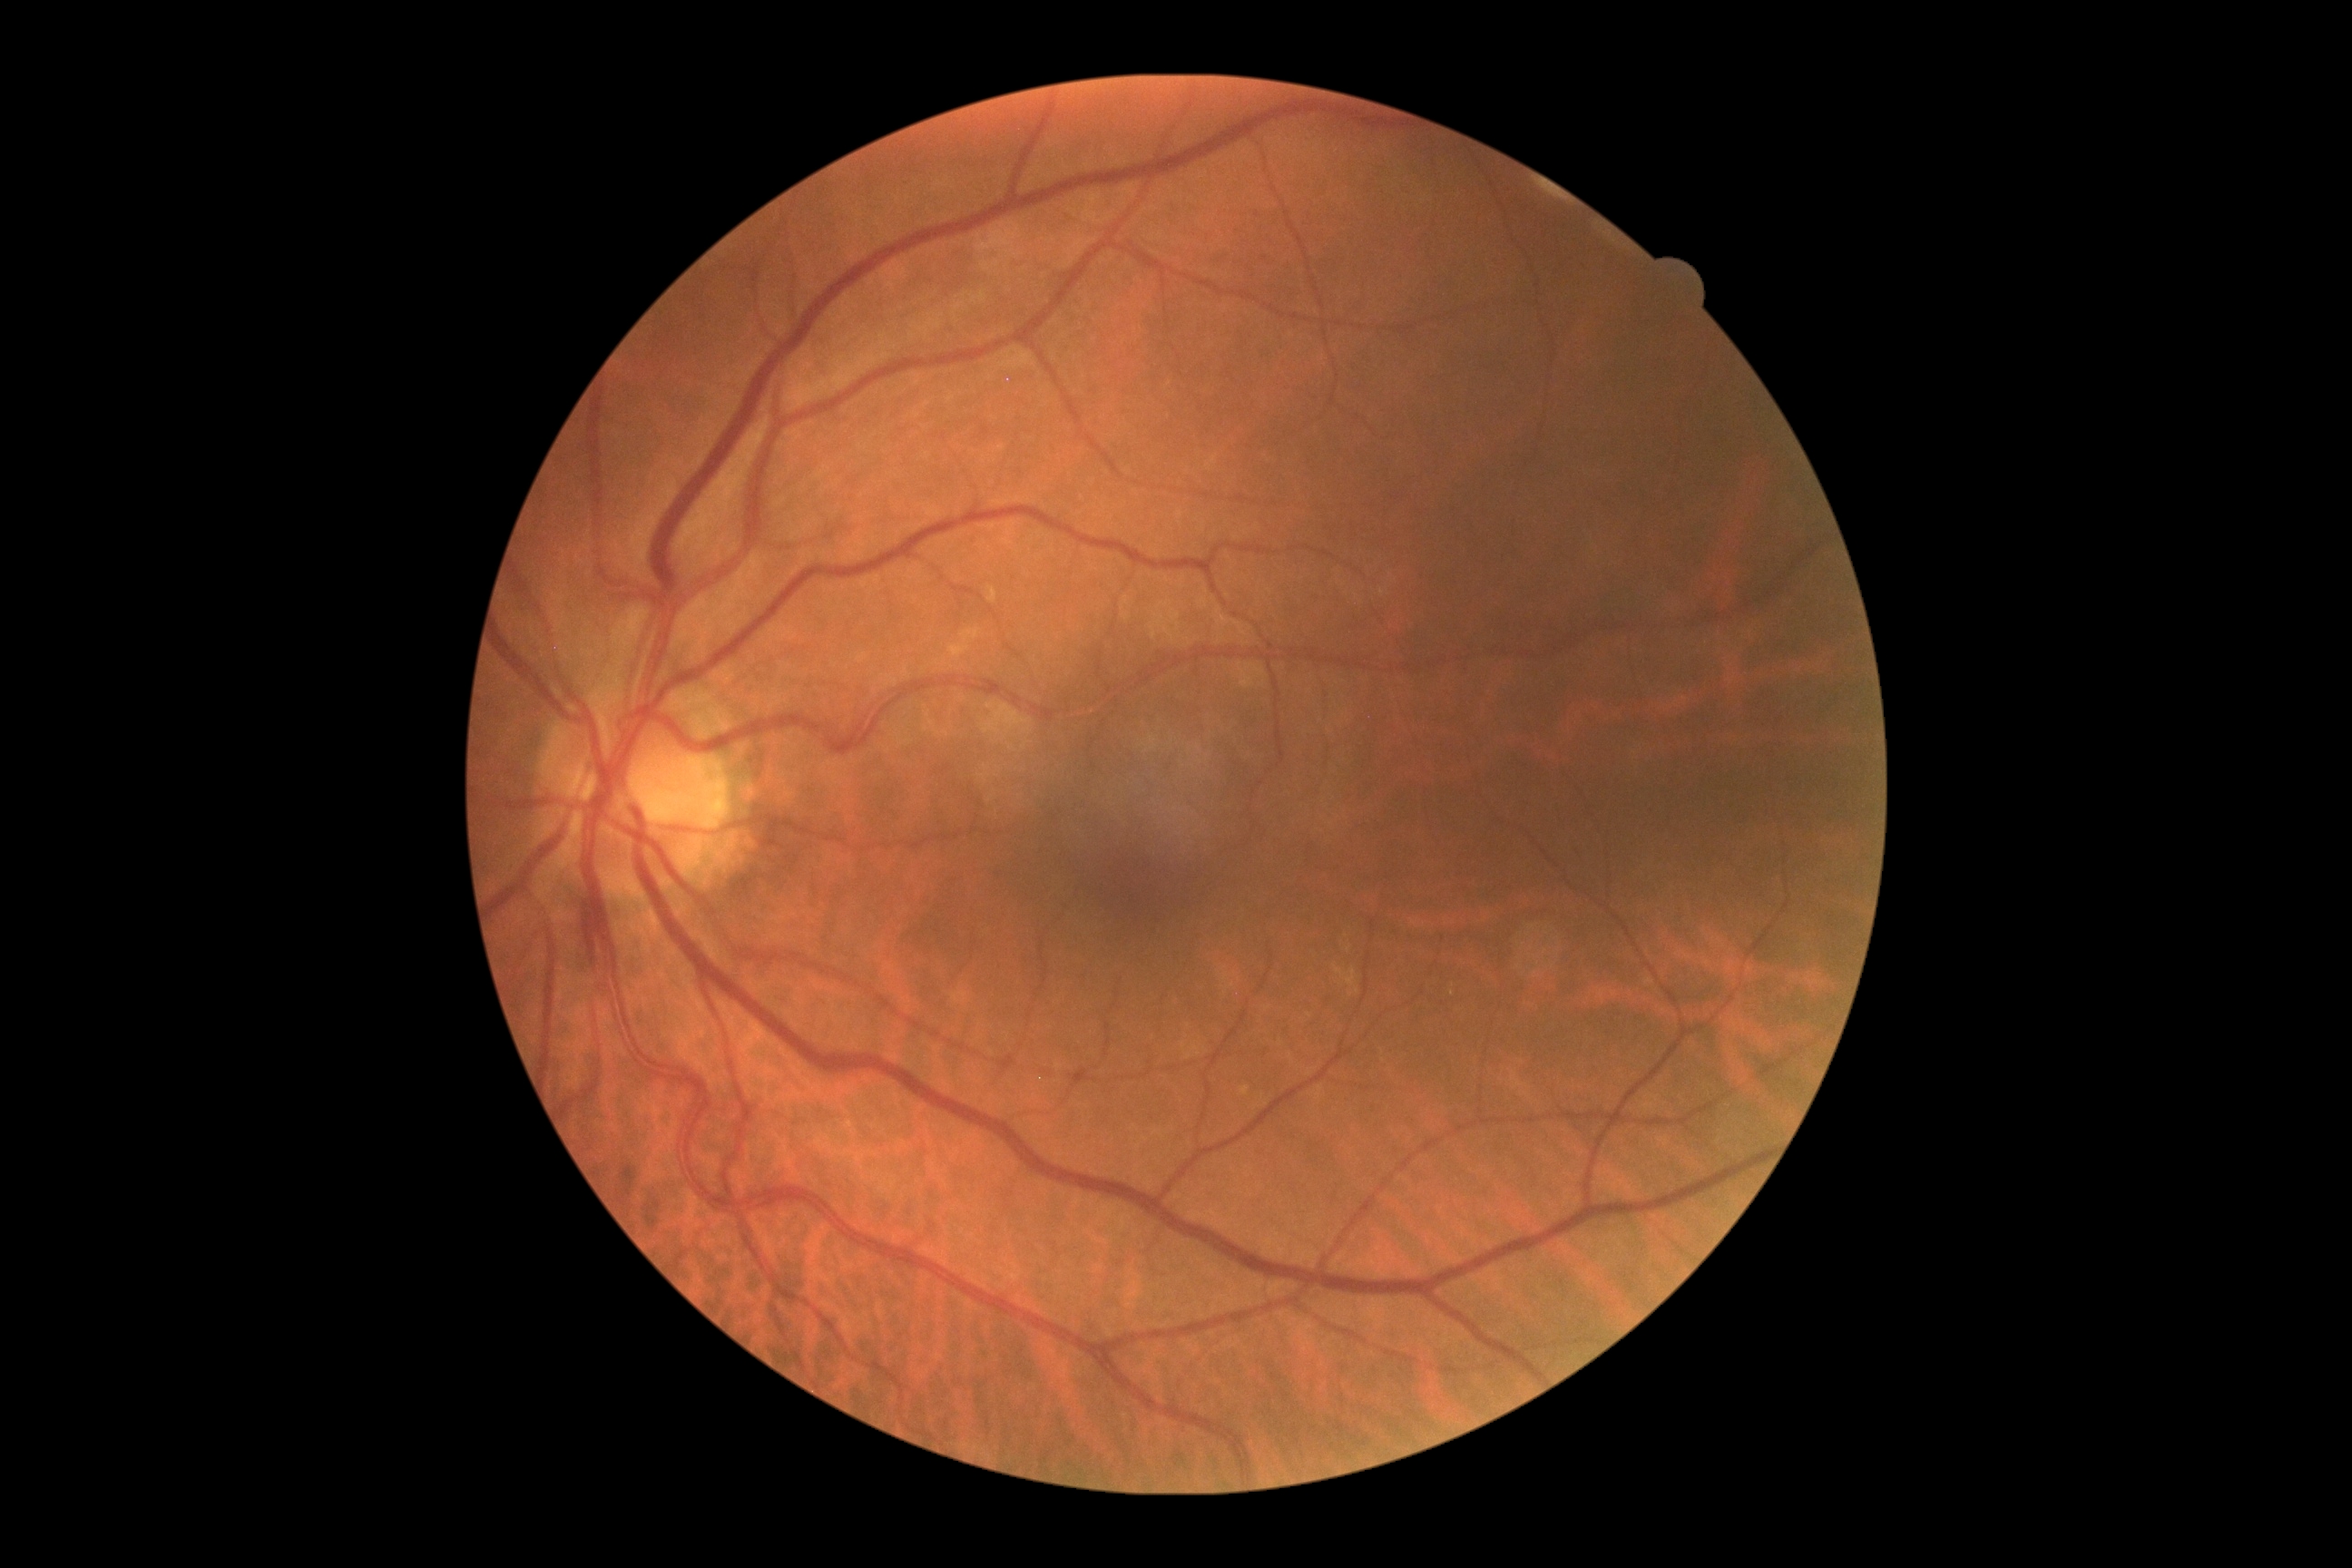

DR: grade 2. The retinopathy is classified as non-proliferative diabetic retinopathy.